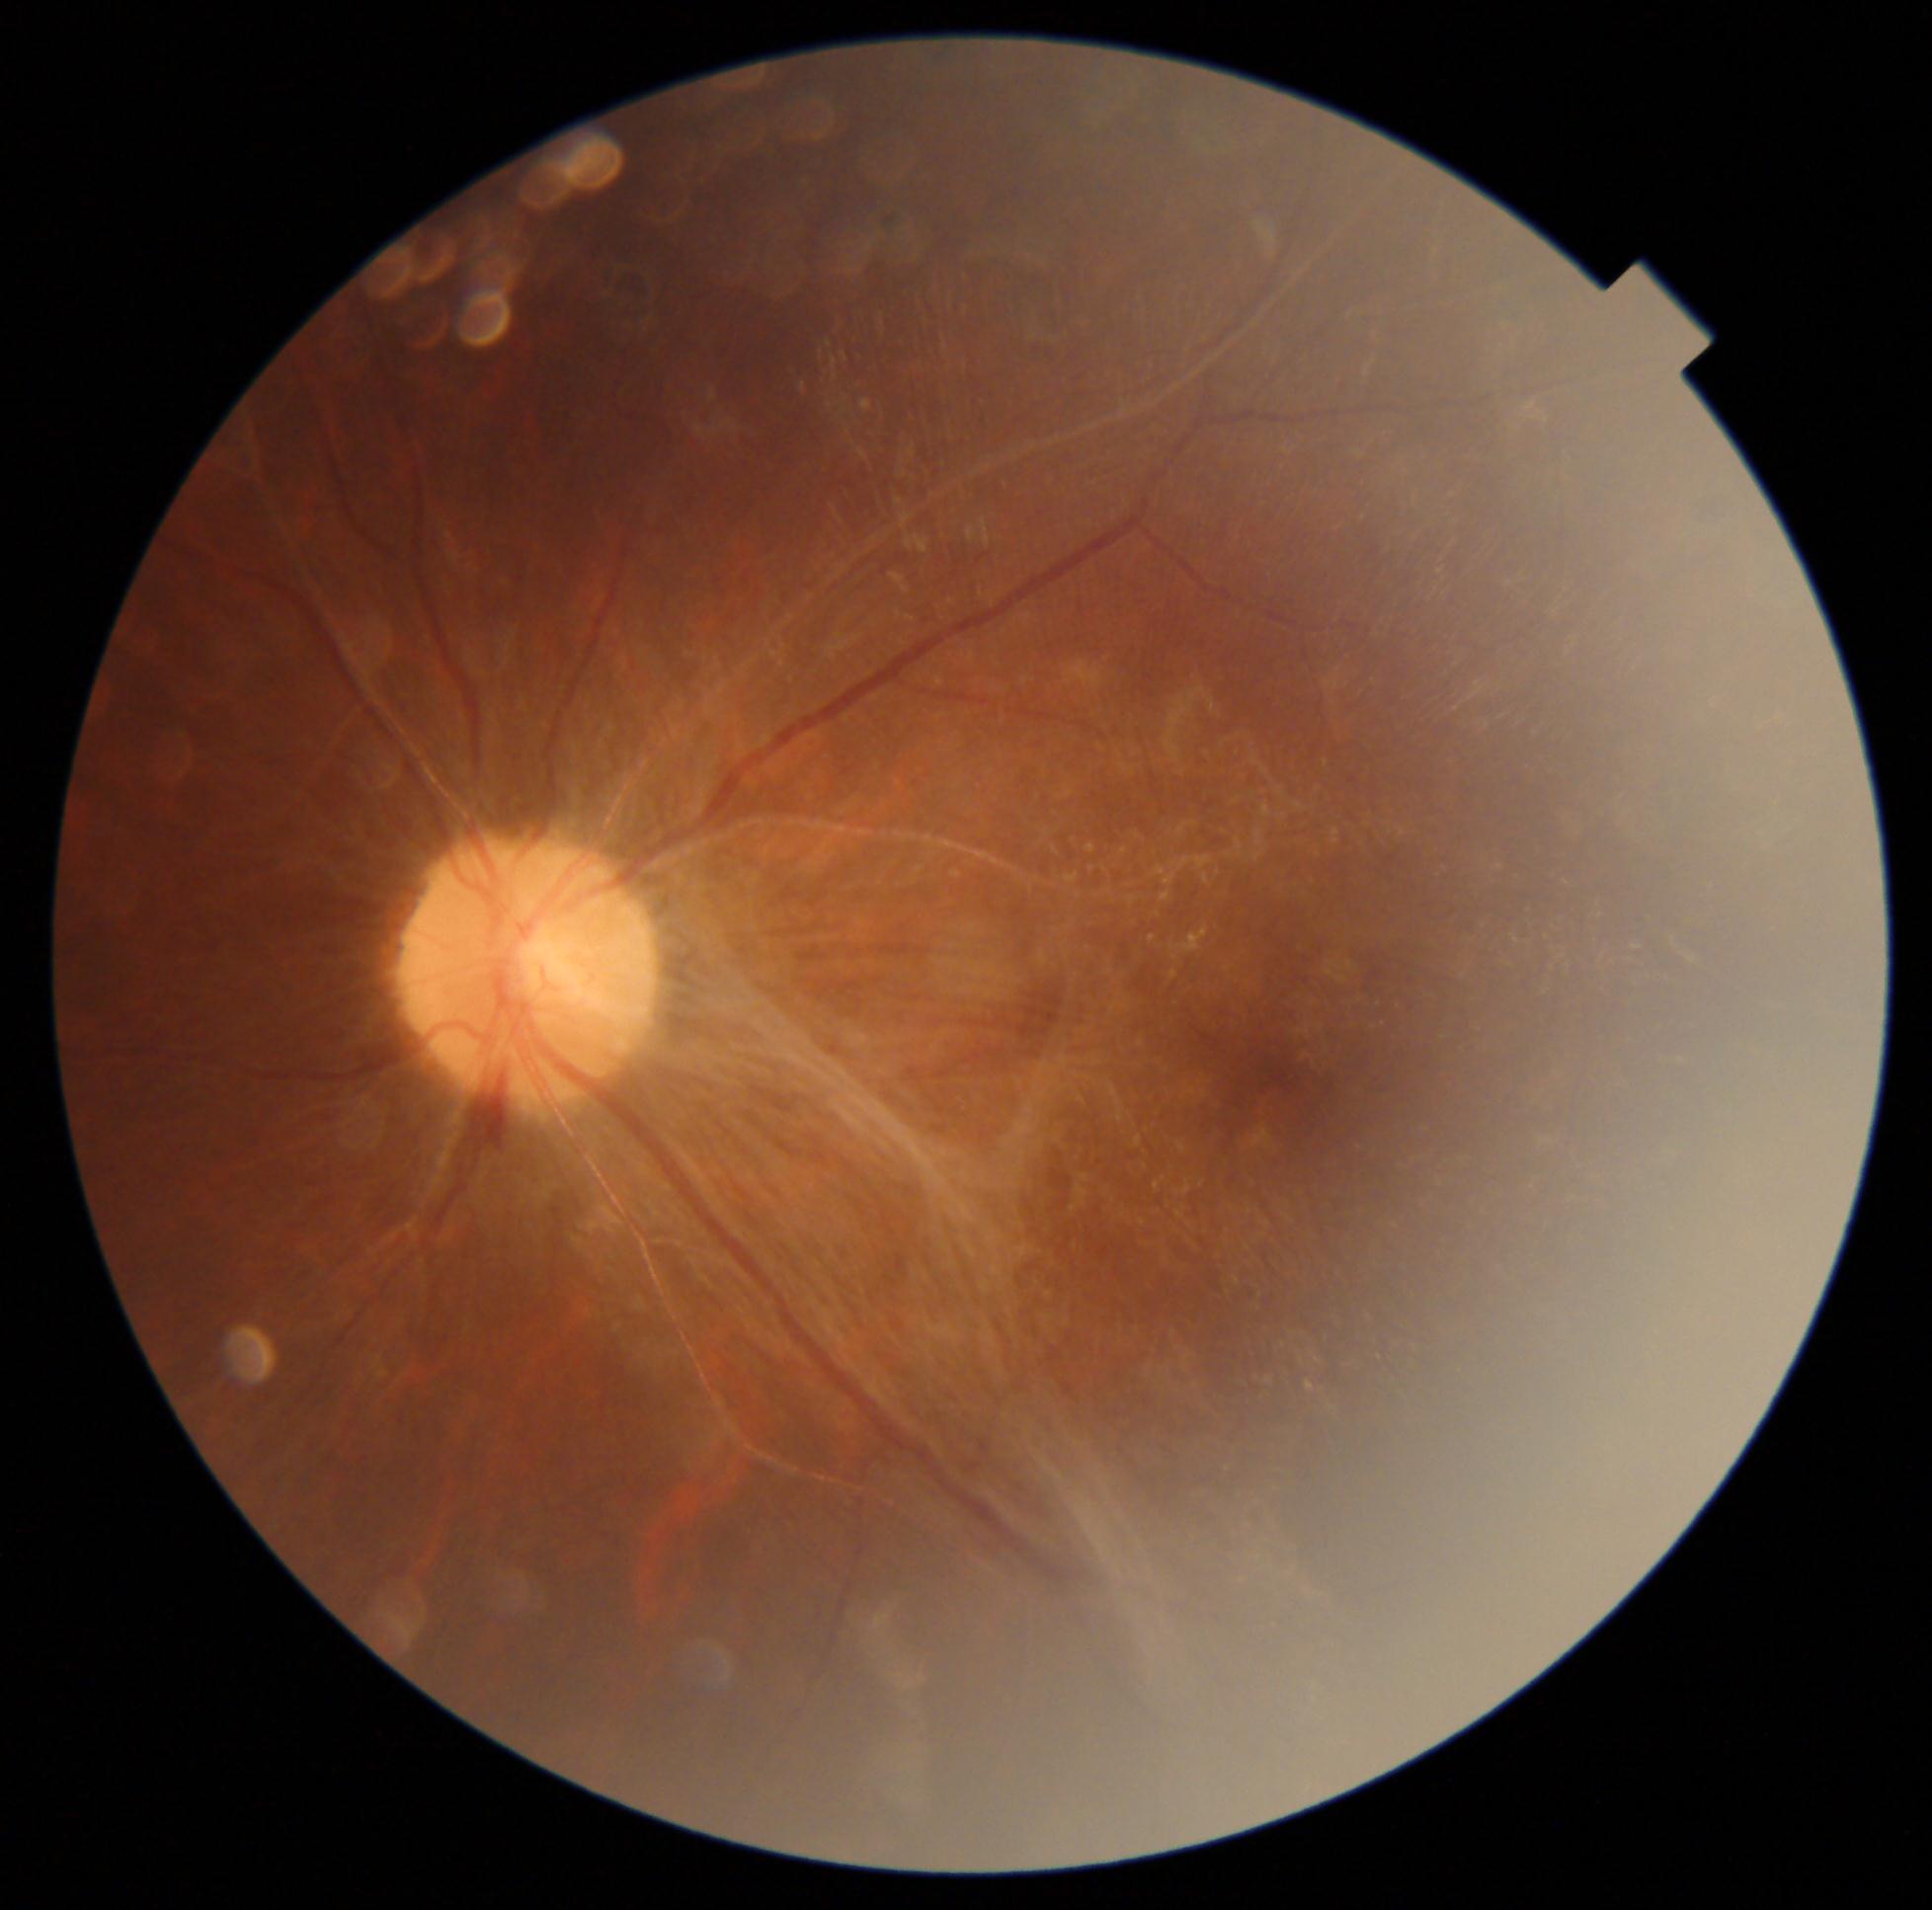

Retinopathy: 4.